Image size 2048x1536
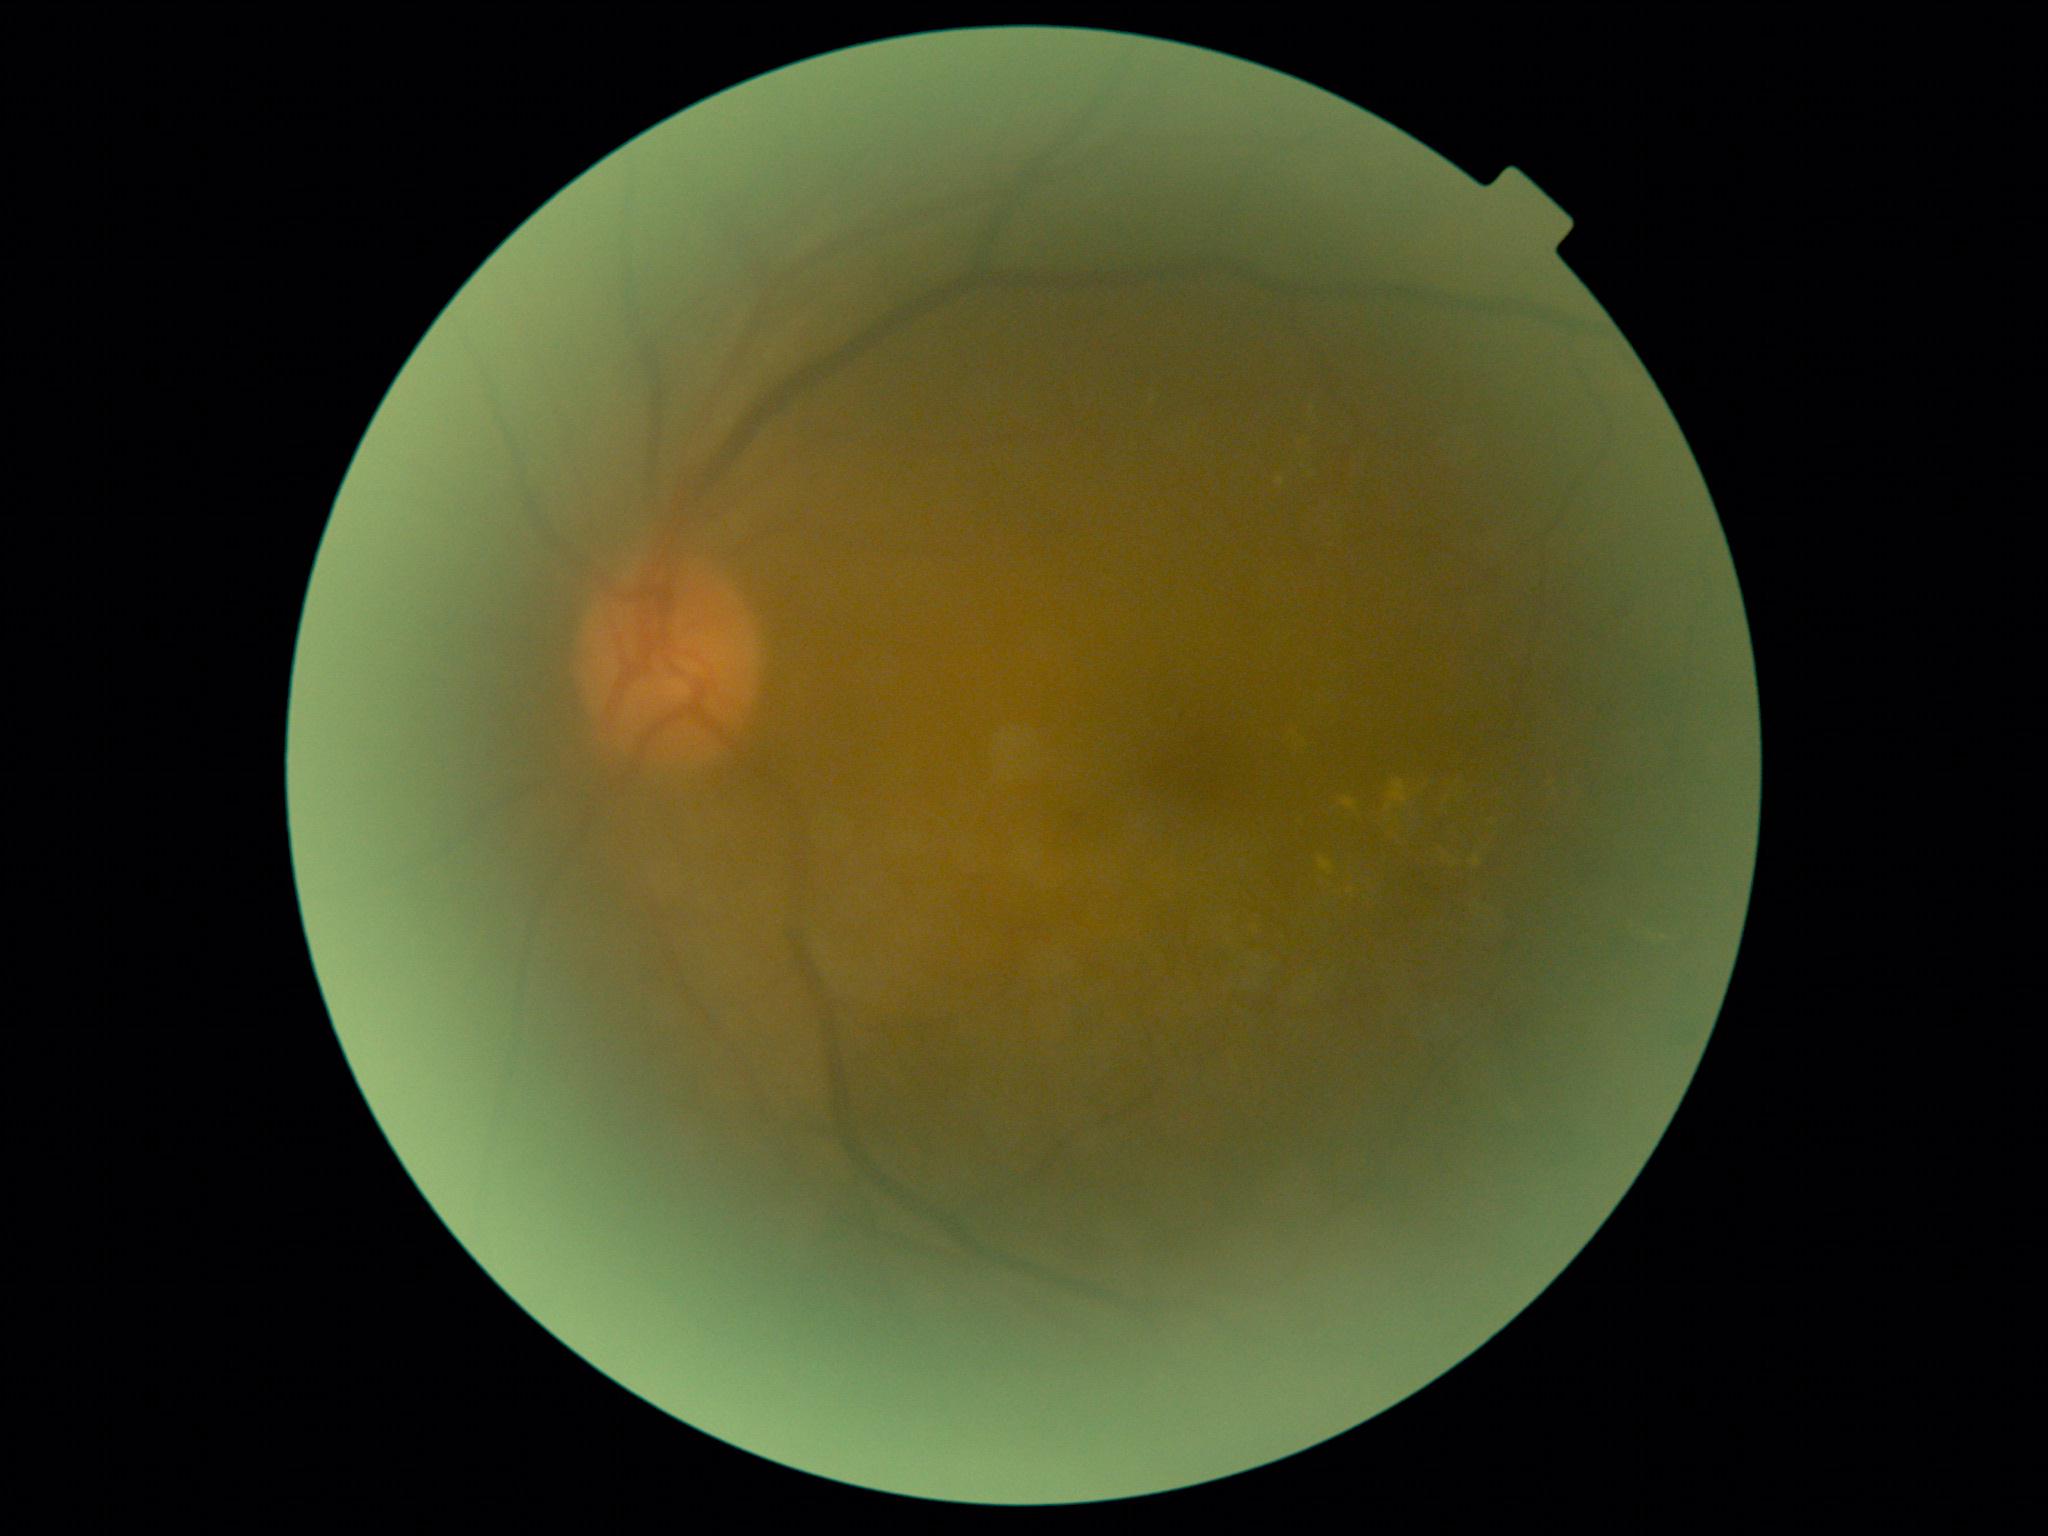

* DR class: non-proliferative diabetic retinopathy
* retinopathy: grade 2